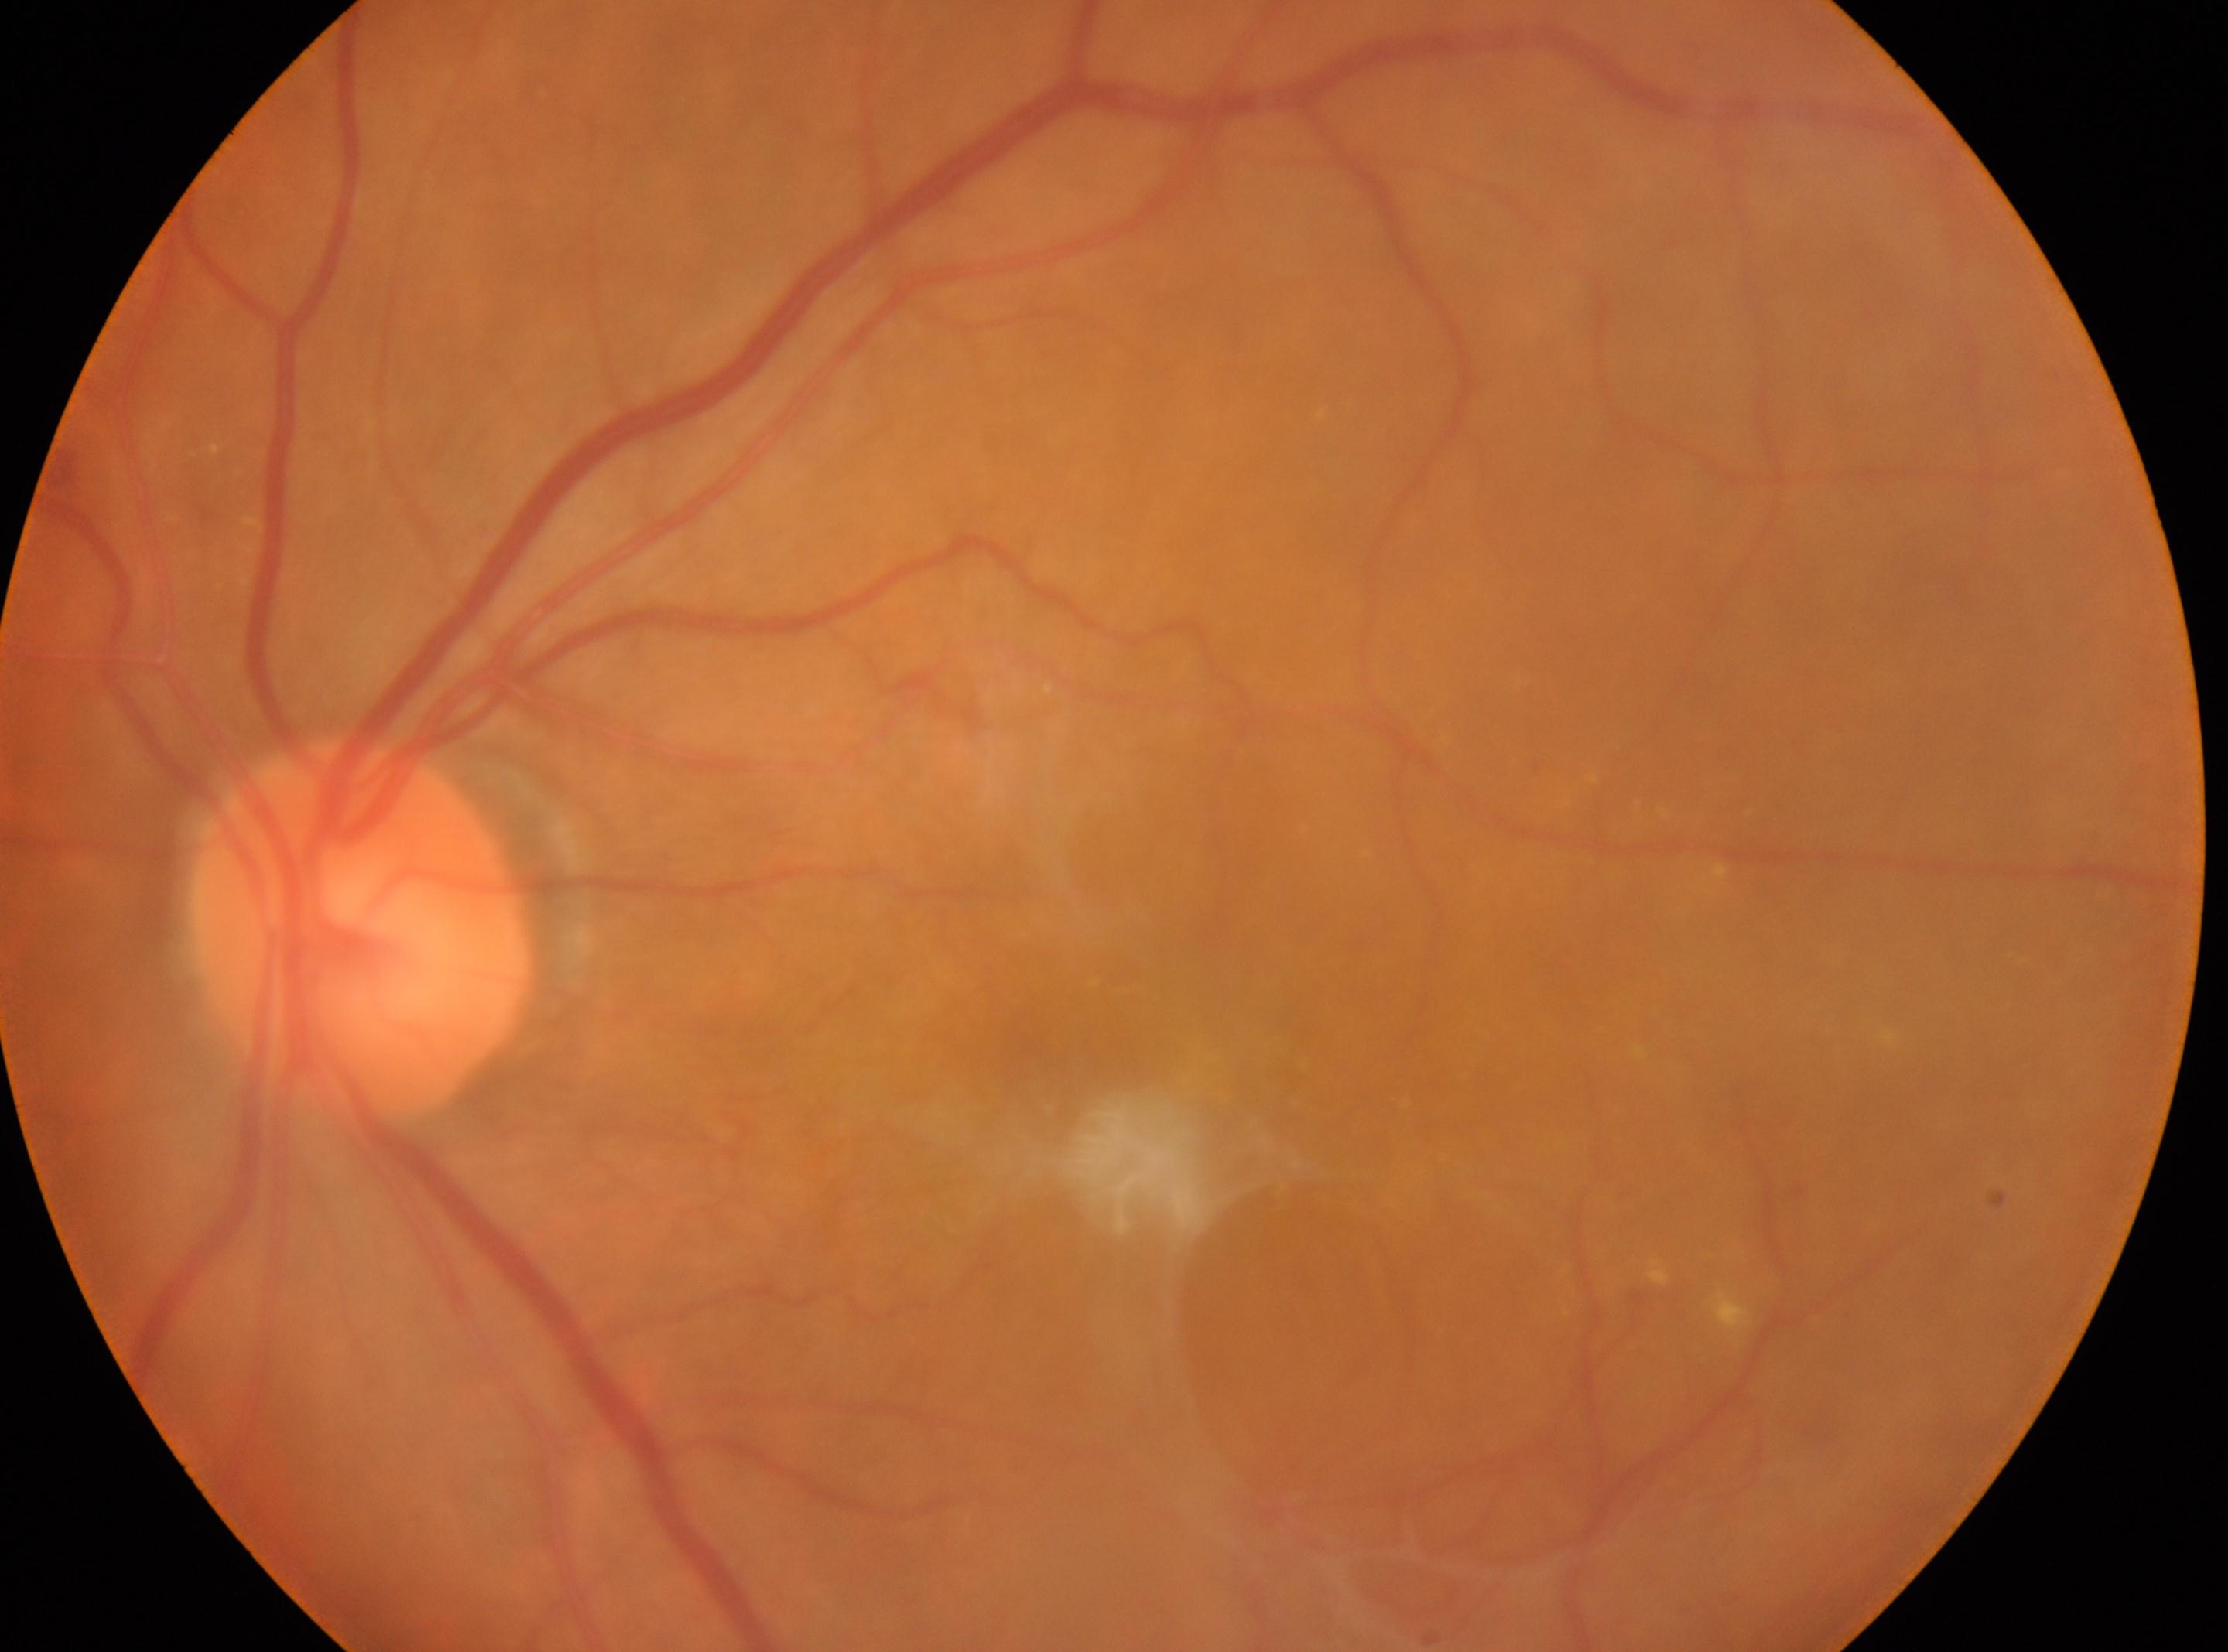
Diabetic retinopathy grade: 4 (PDR).
Imaged eye: left.
Foveal center located at (1063, 1044).
Optic disc: (361, 927).